CFP; 45° field of view — 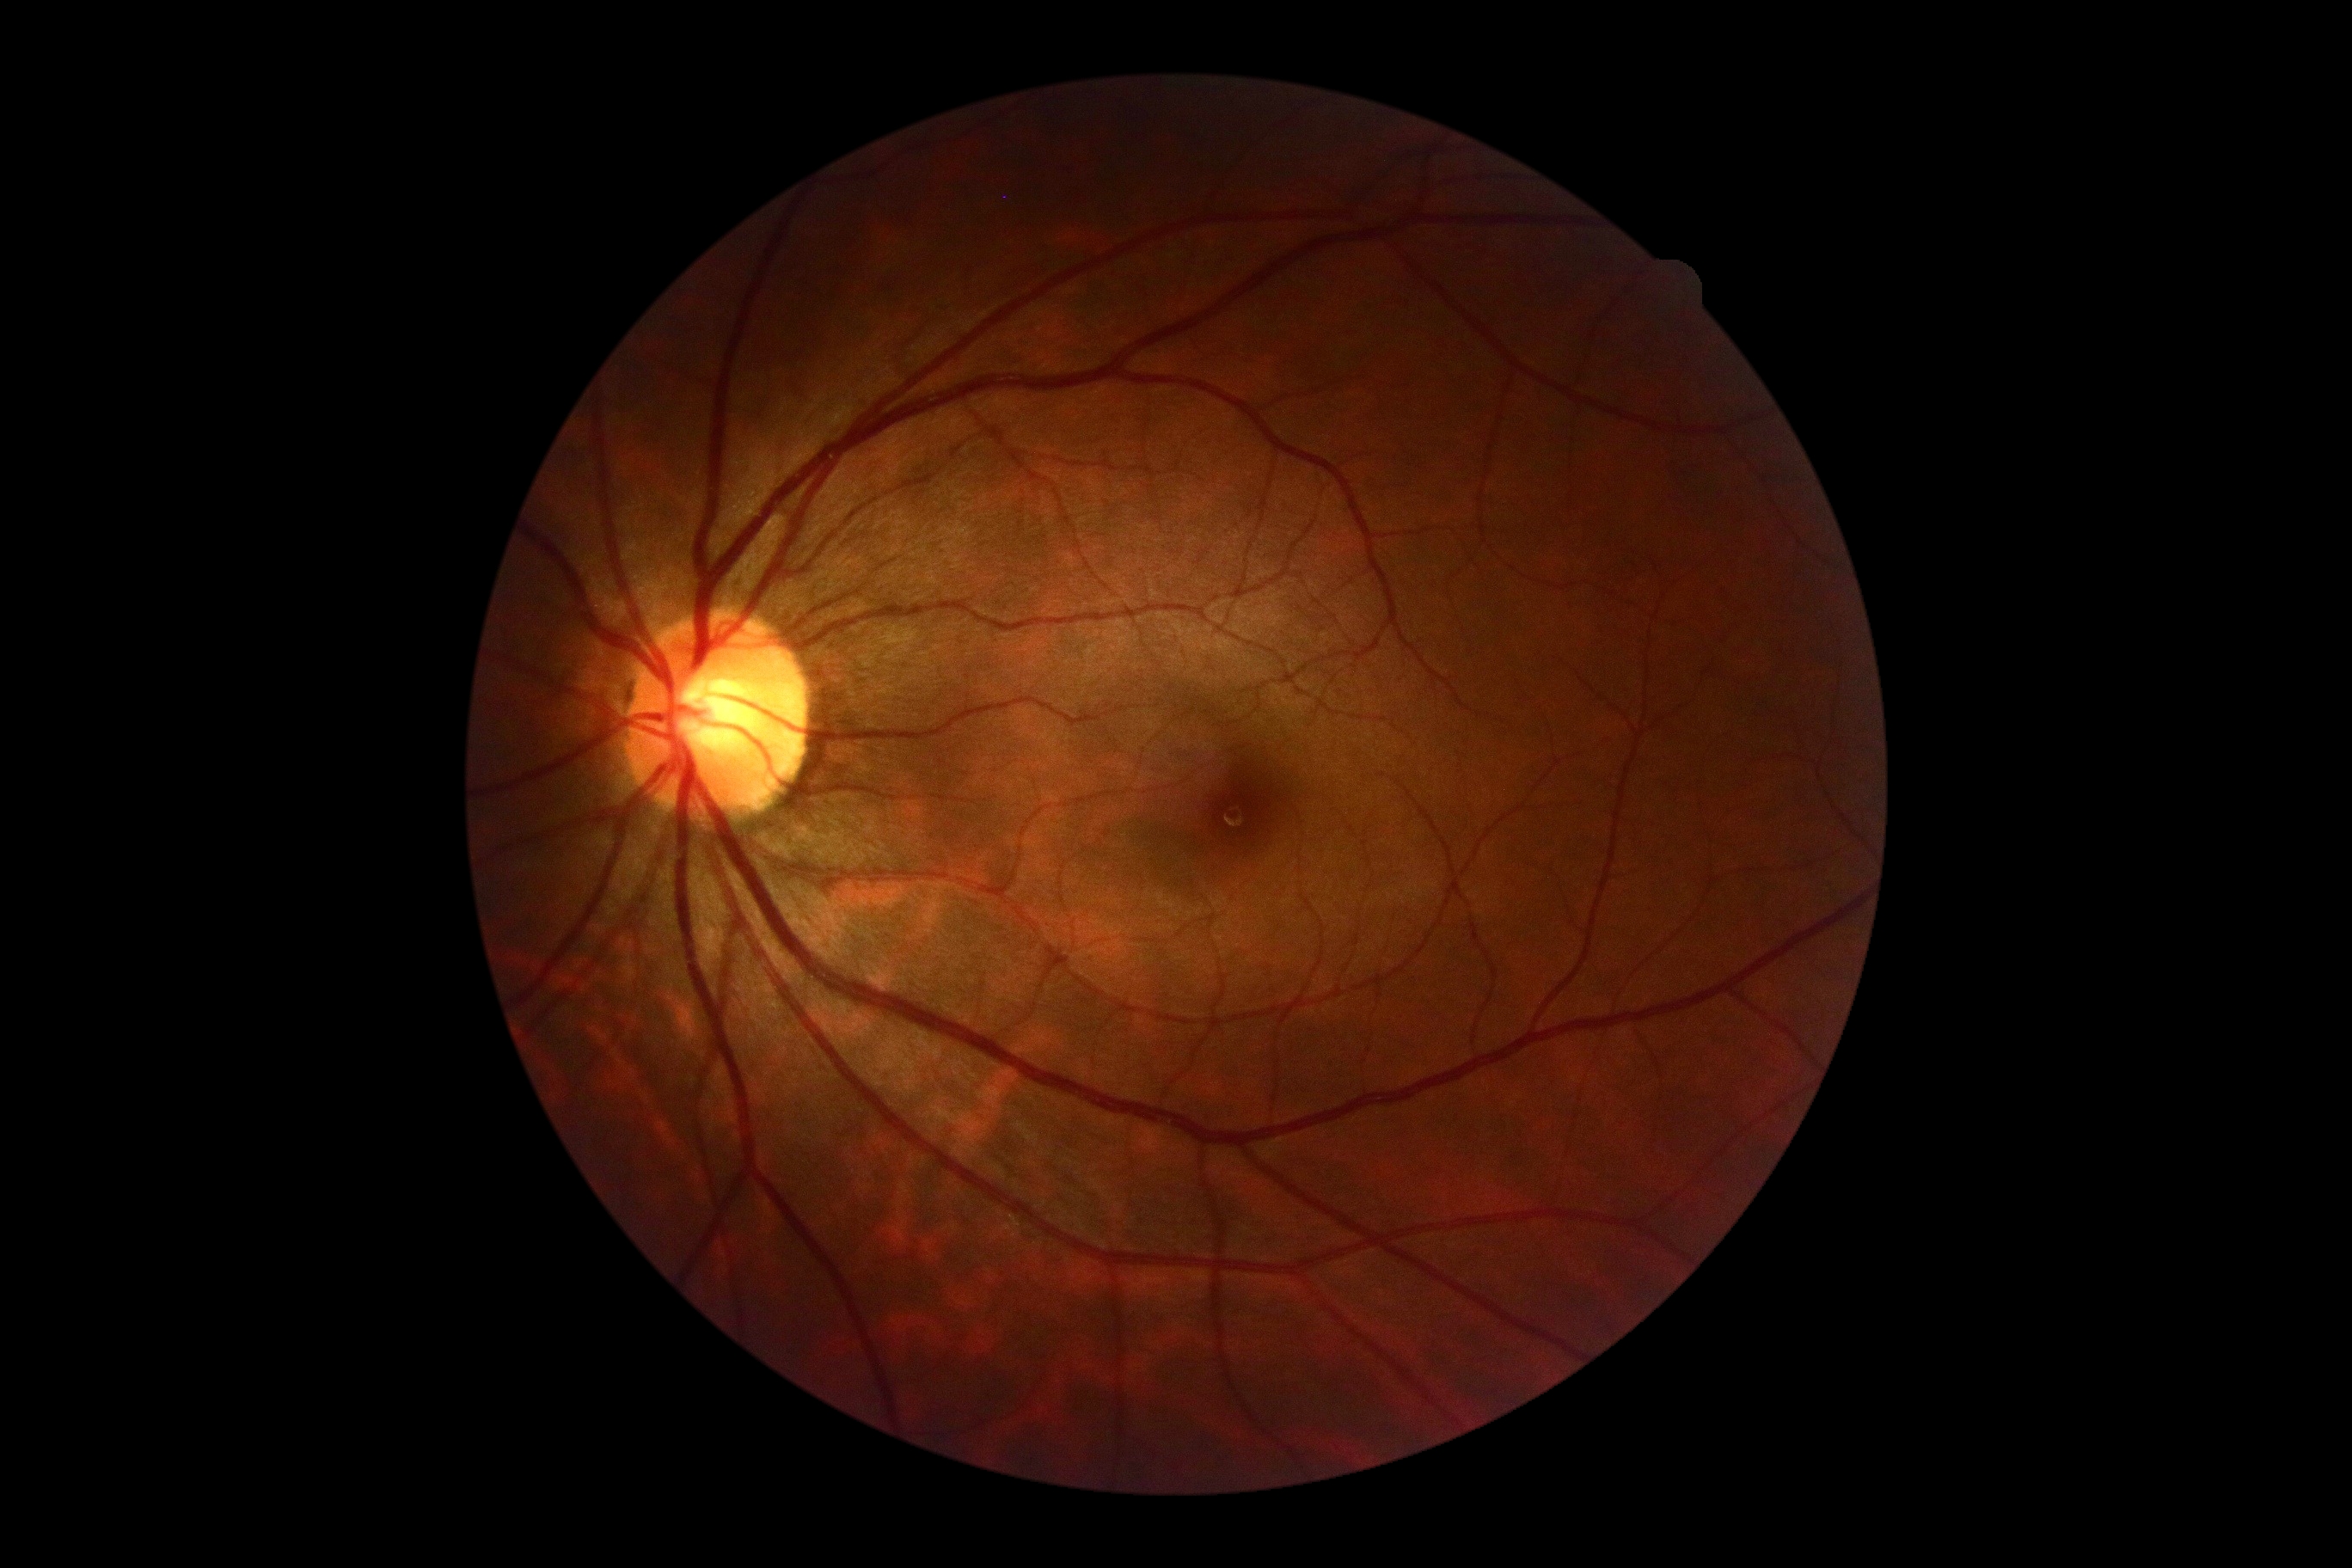 DR impression = negative for DR; retinopathy = grade 0.